Refraction: +1.25 -0.75 × 80°. Intraocular pressure 14 mmHg. Age 53. Pachymetry: 526 µm: 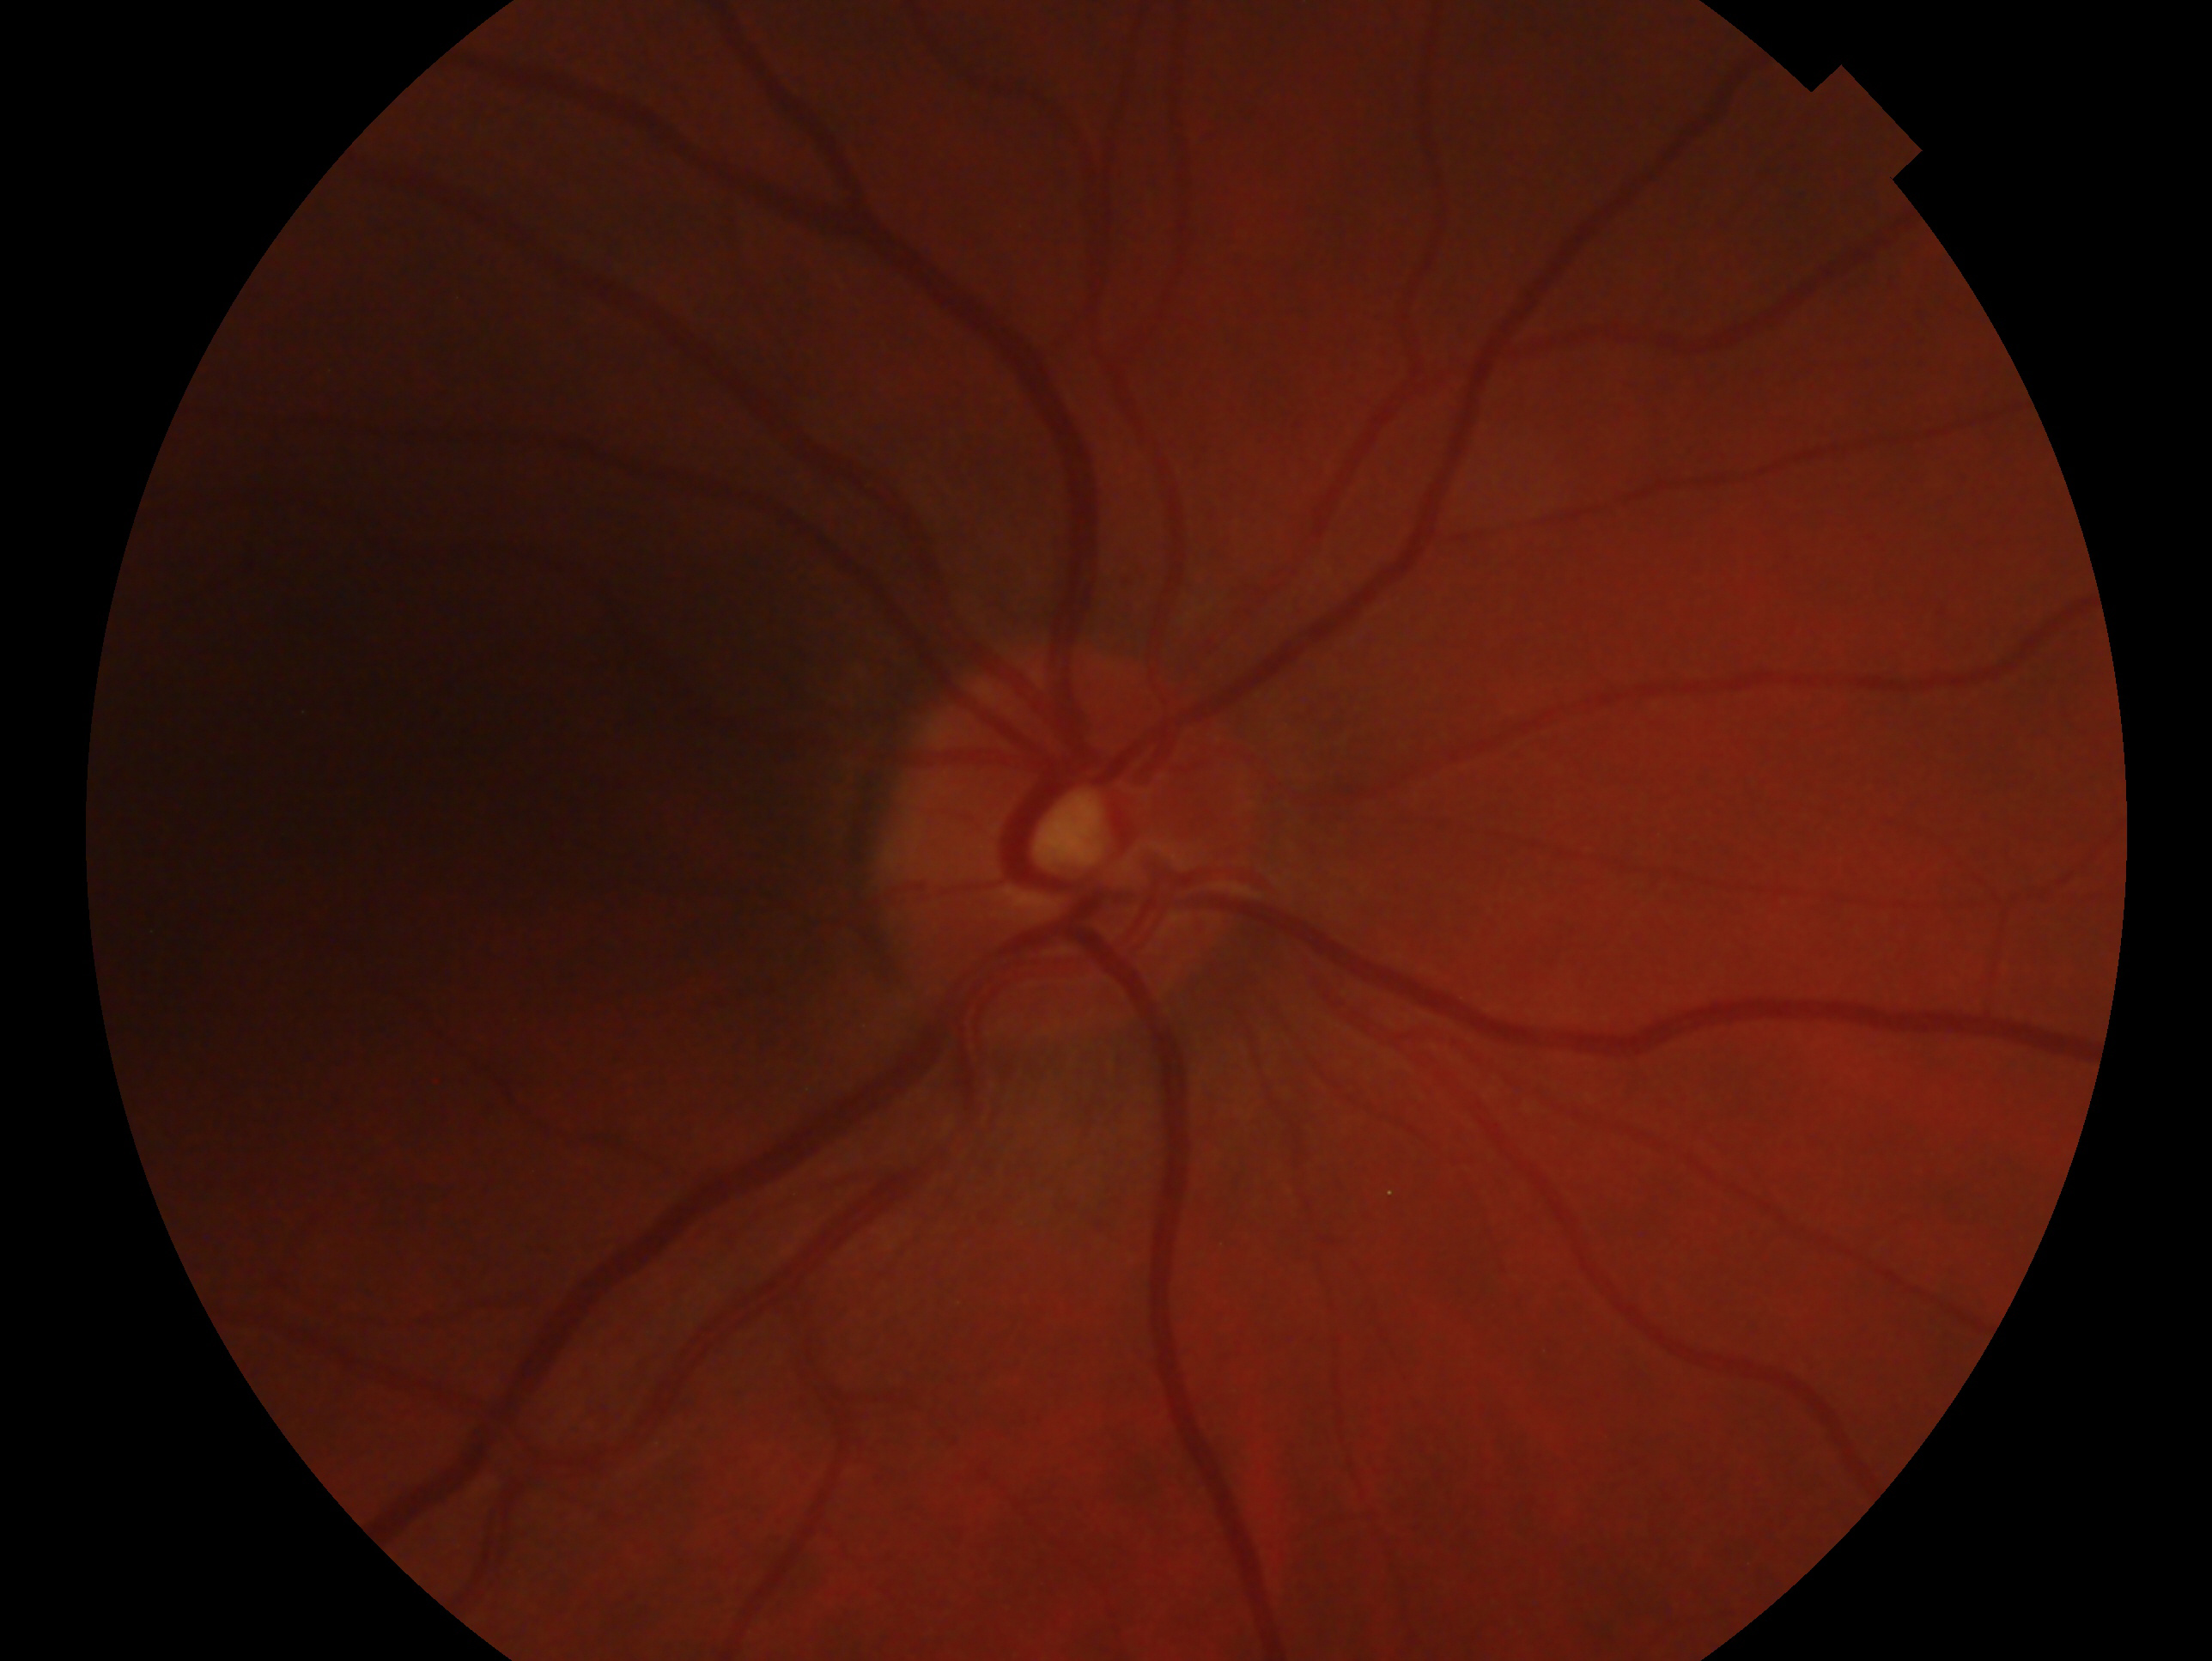
The image shows the oculus dexter. Diagnosis — glaucoma suspect.